Retinal fundus photograph: 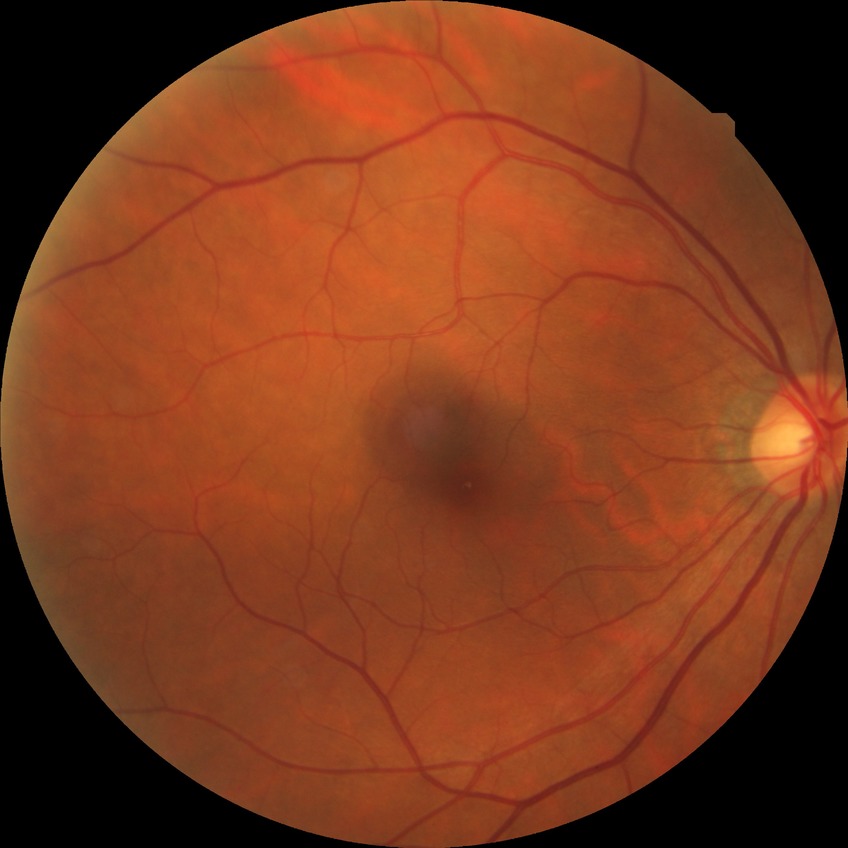 diabetic retinopathy grade=no diabetic retinopathy.